50° field of view — 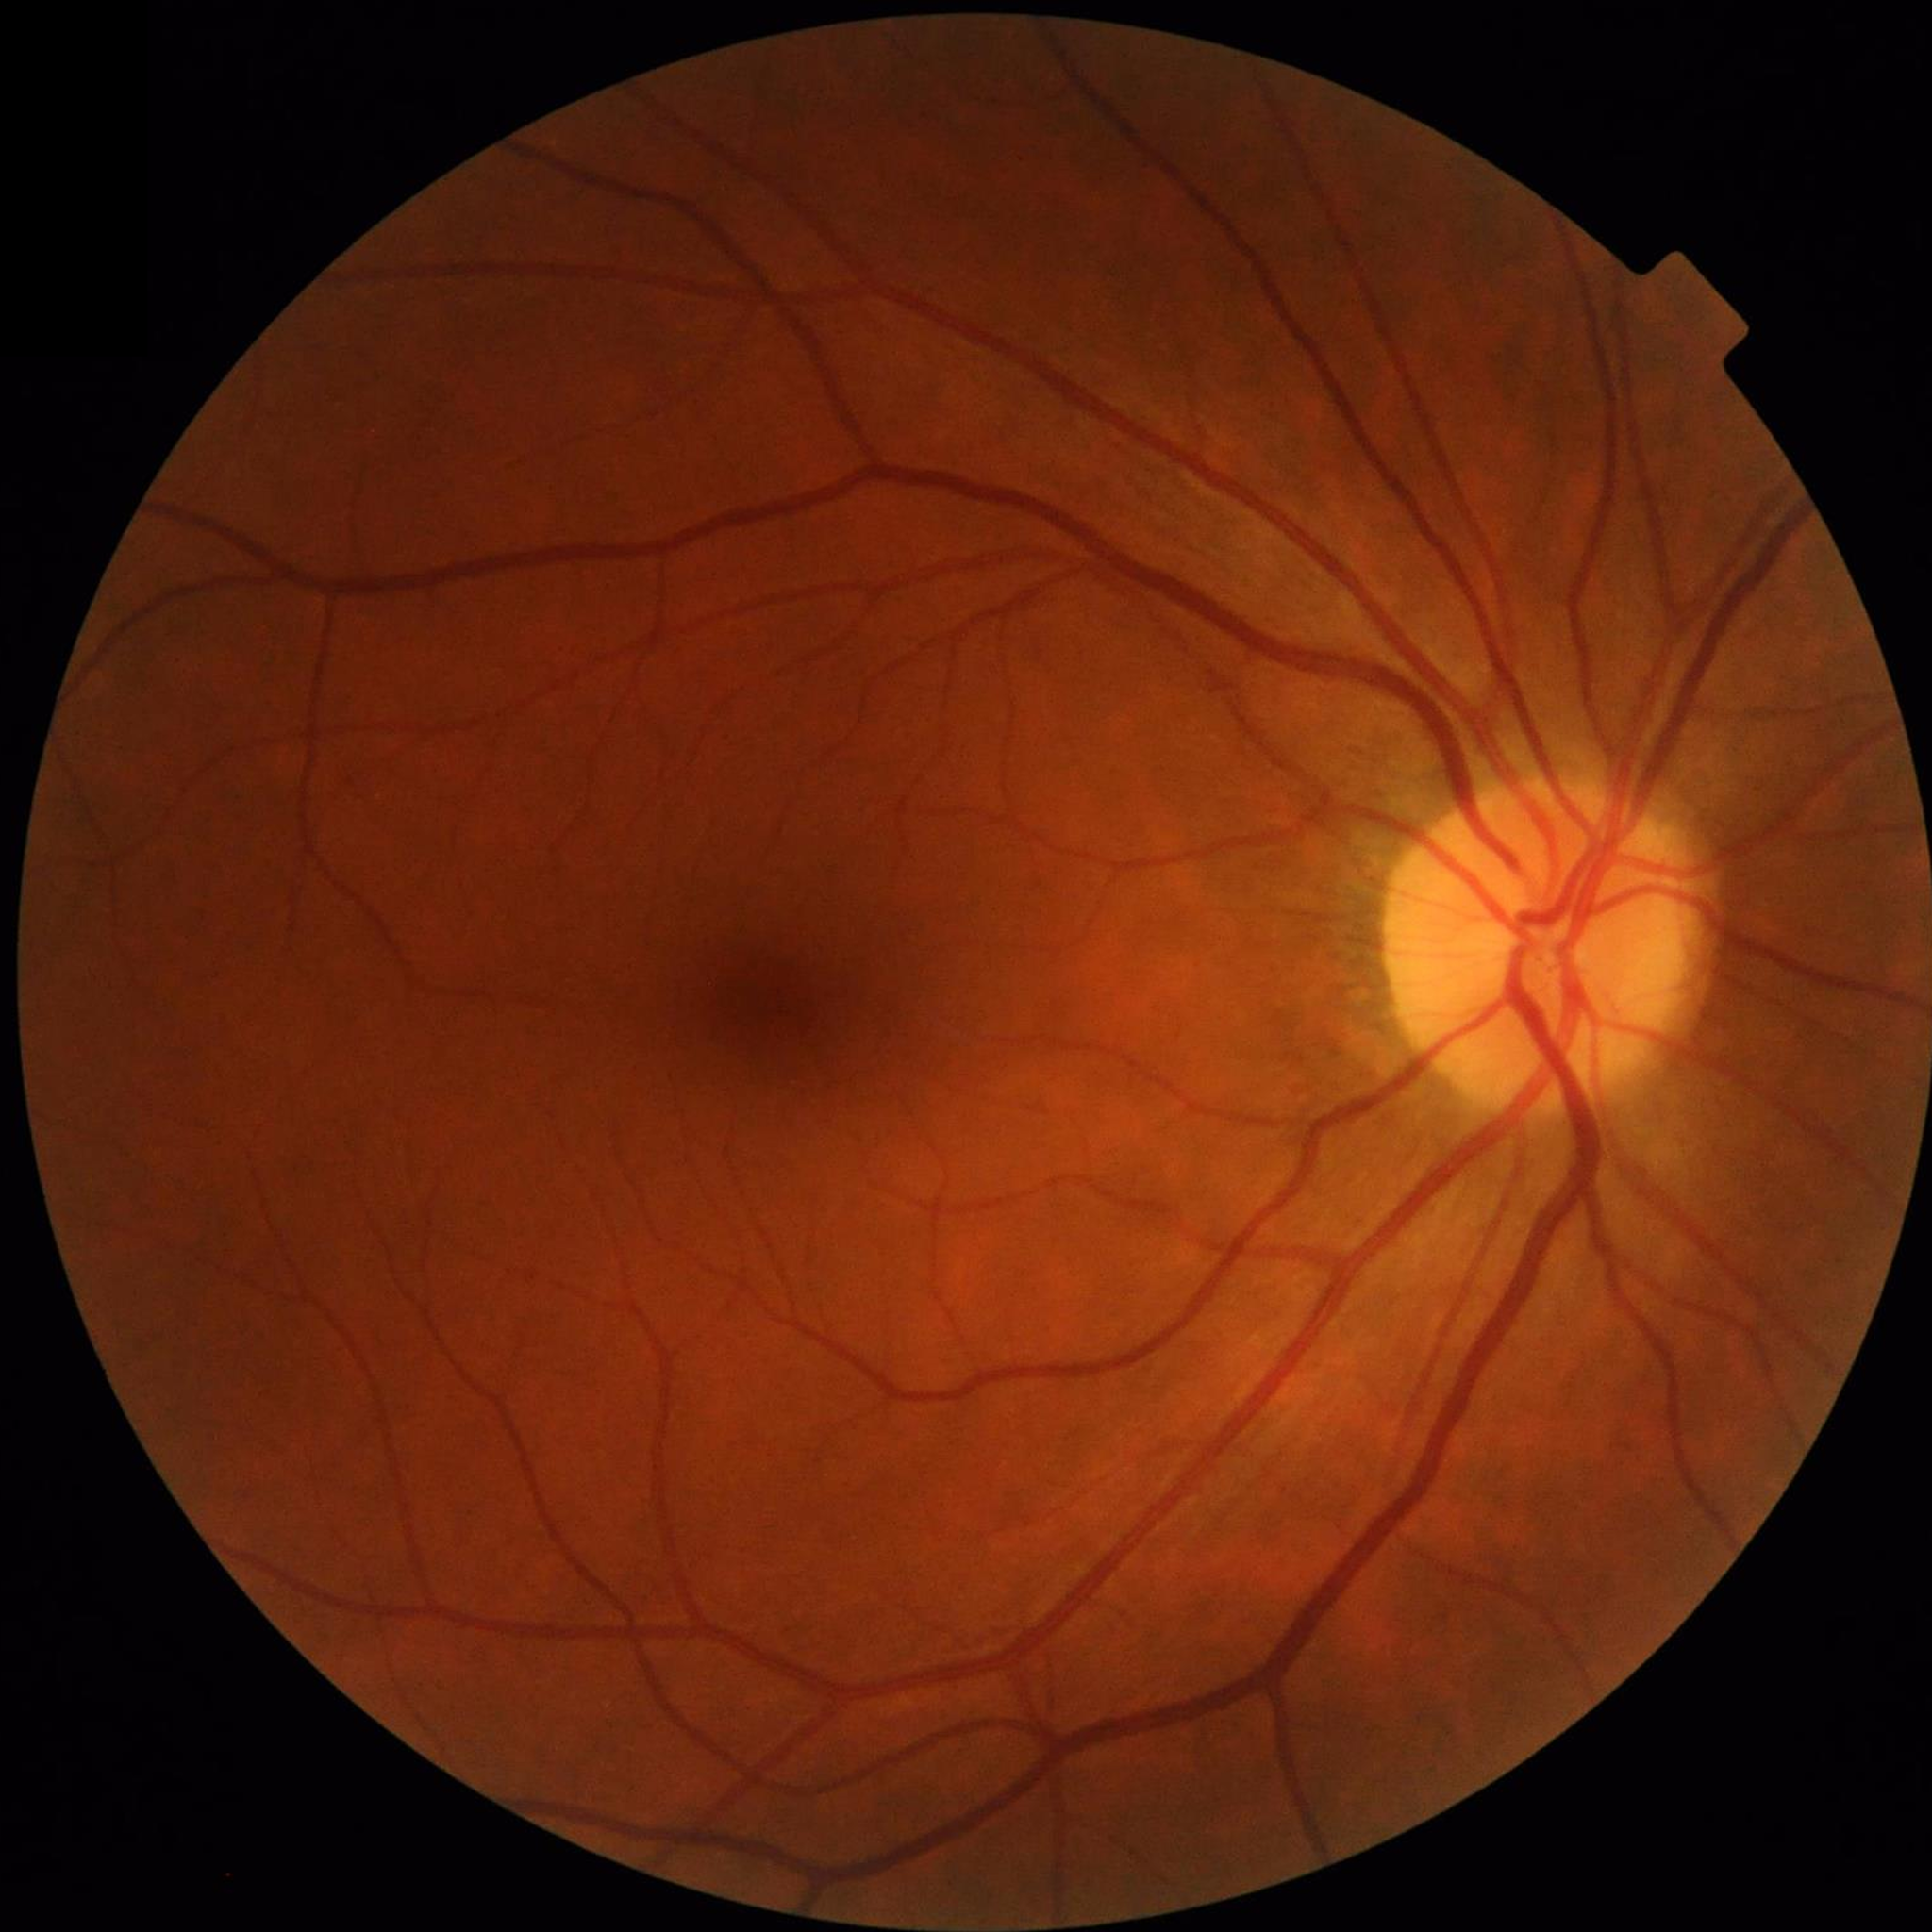
Clinical diagnosis = no AMD, DR, or glaucomatous findings.